2184 x 1690 pixels.
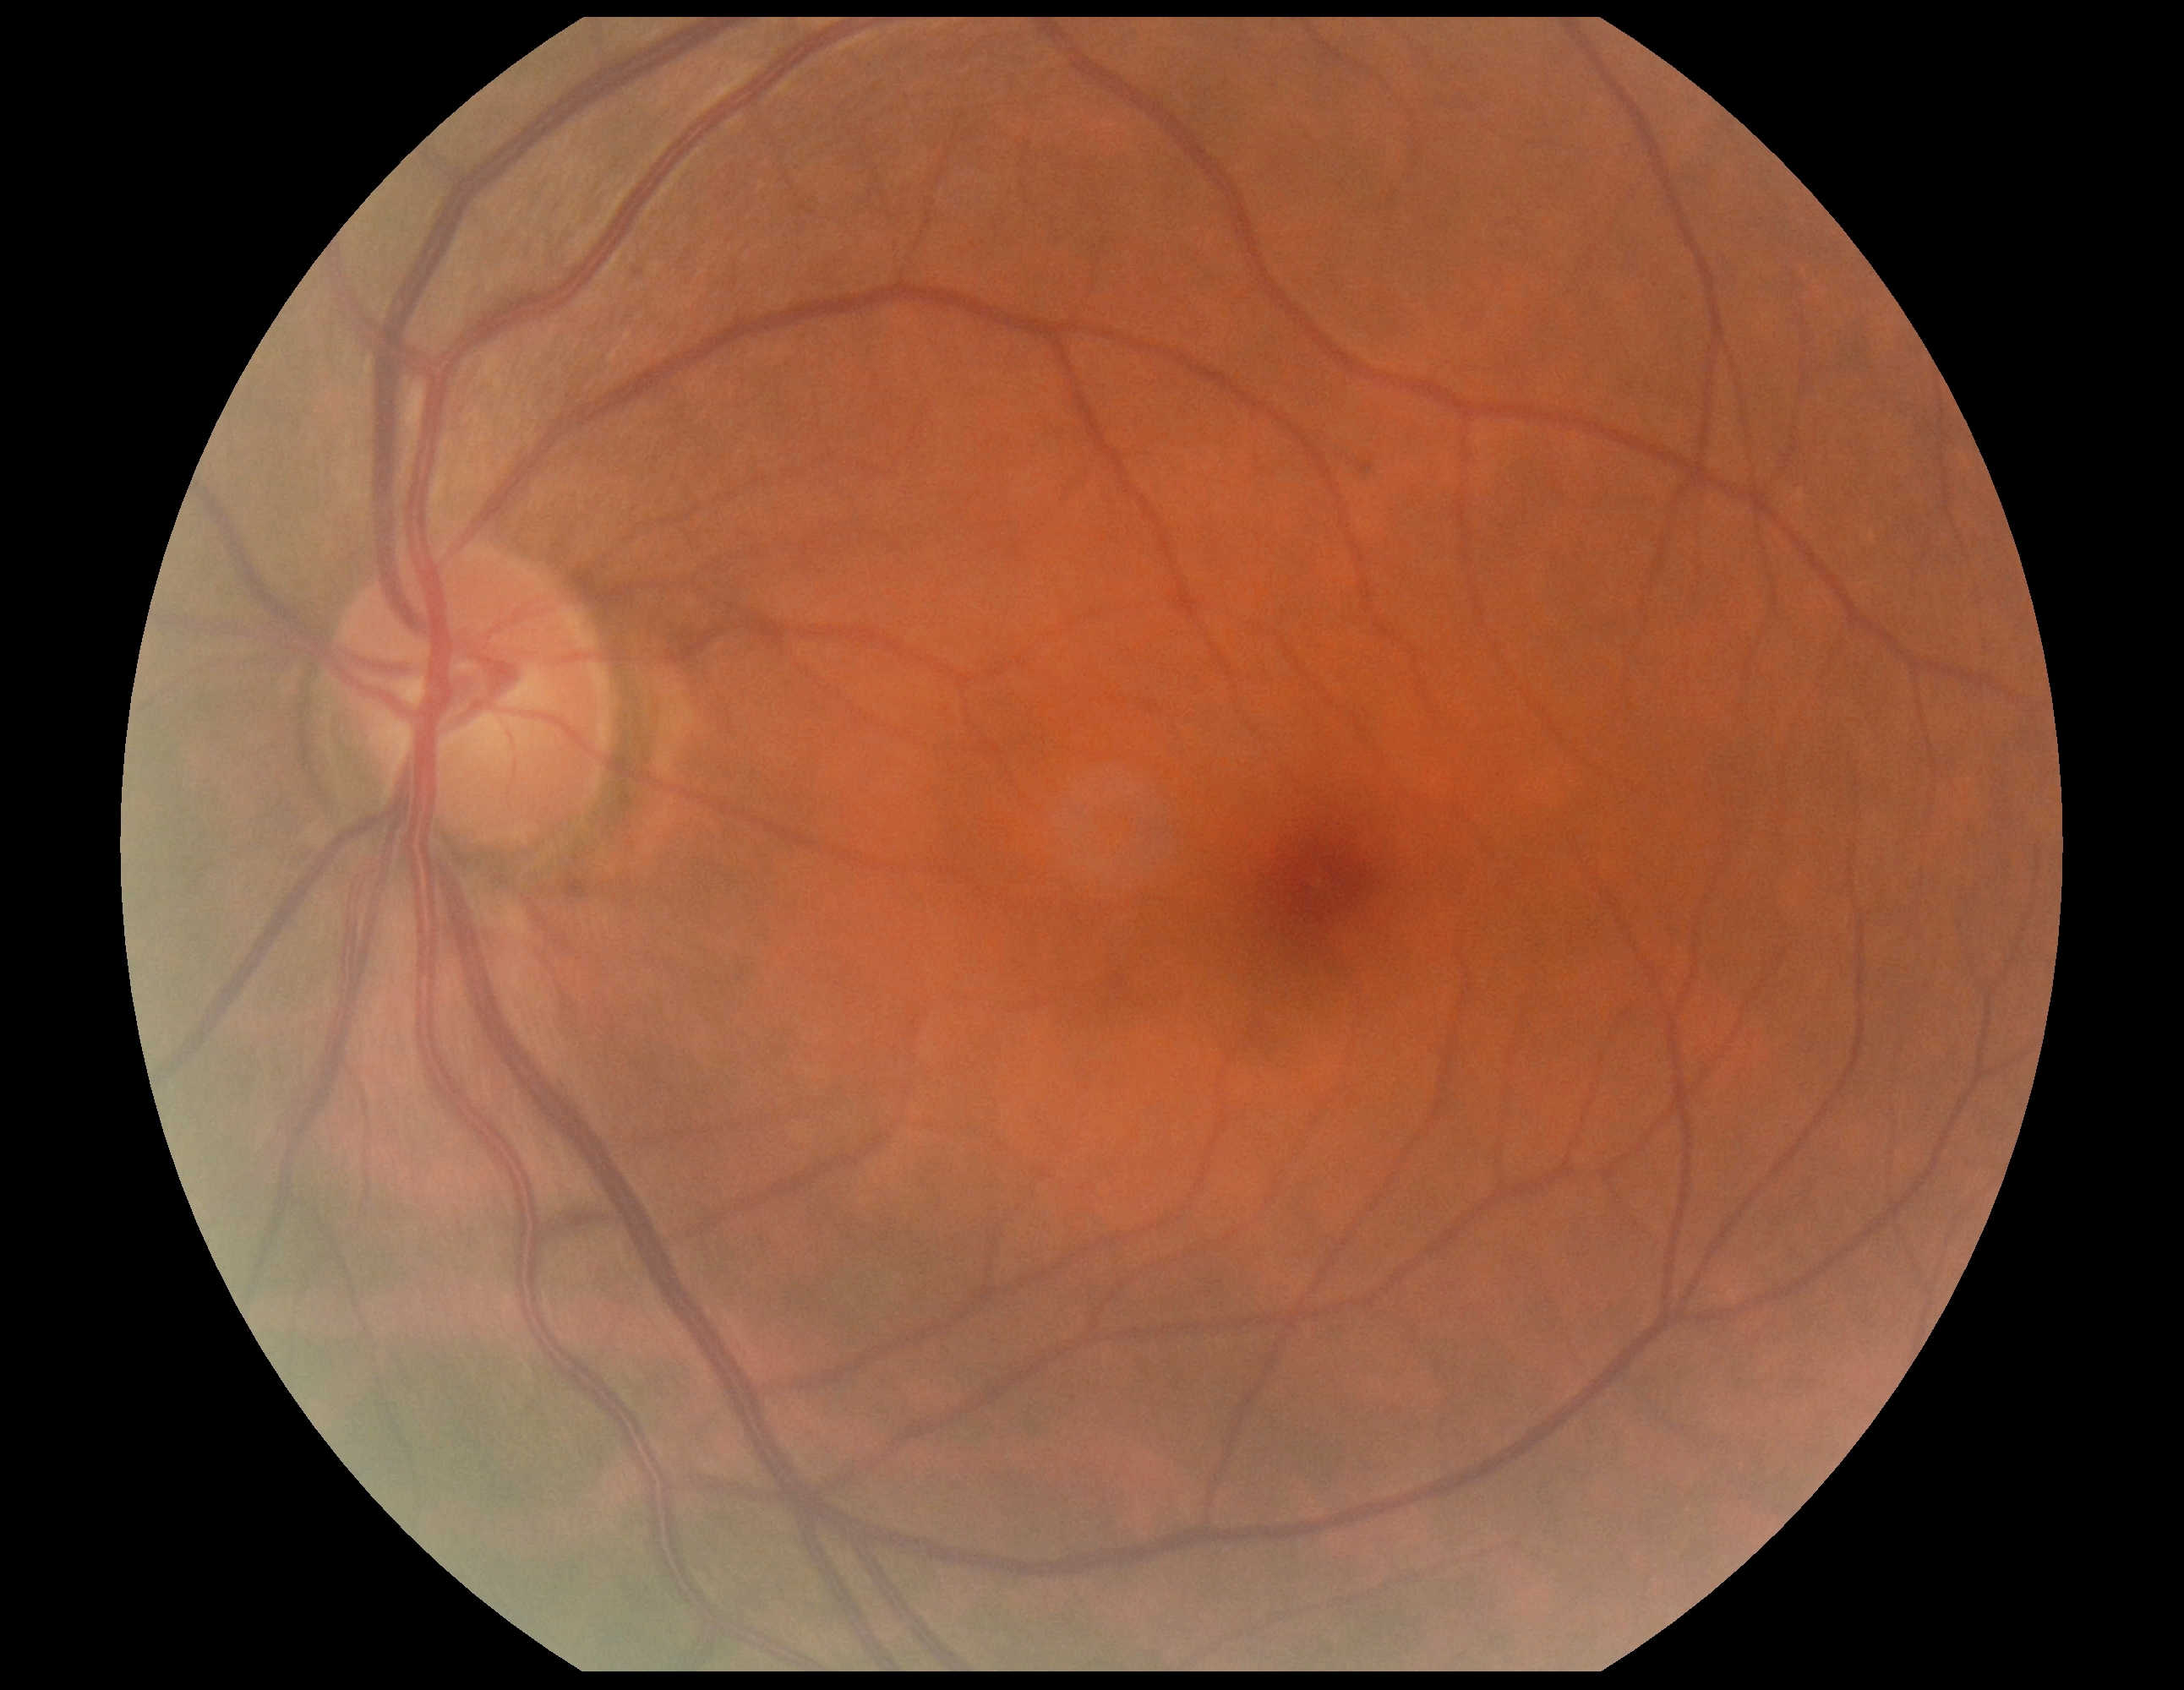 Diabetic retinopathy (DR) is no apparent diabetic retinopathy (grade 0) — no visible signs of diabetic retinopathy. No DR findings.